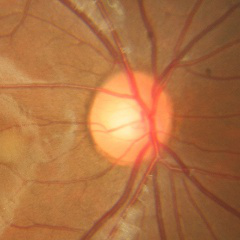
Glaucoma assessment: no glaucomatous optic neuropathy.